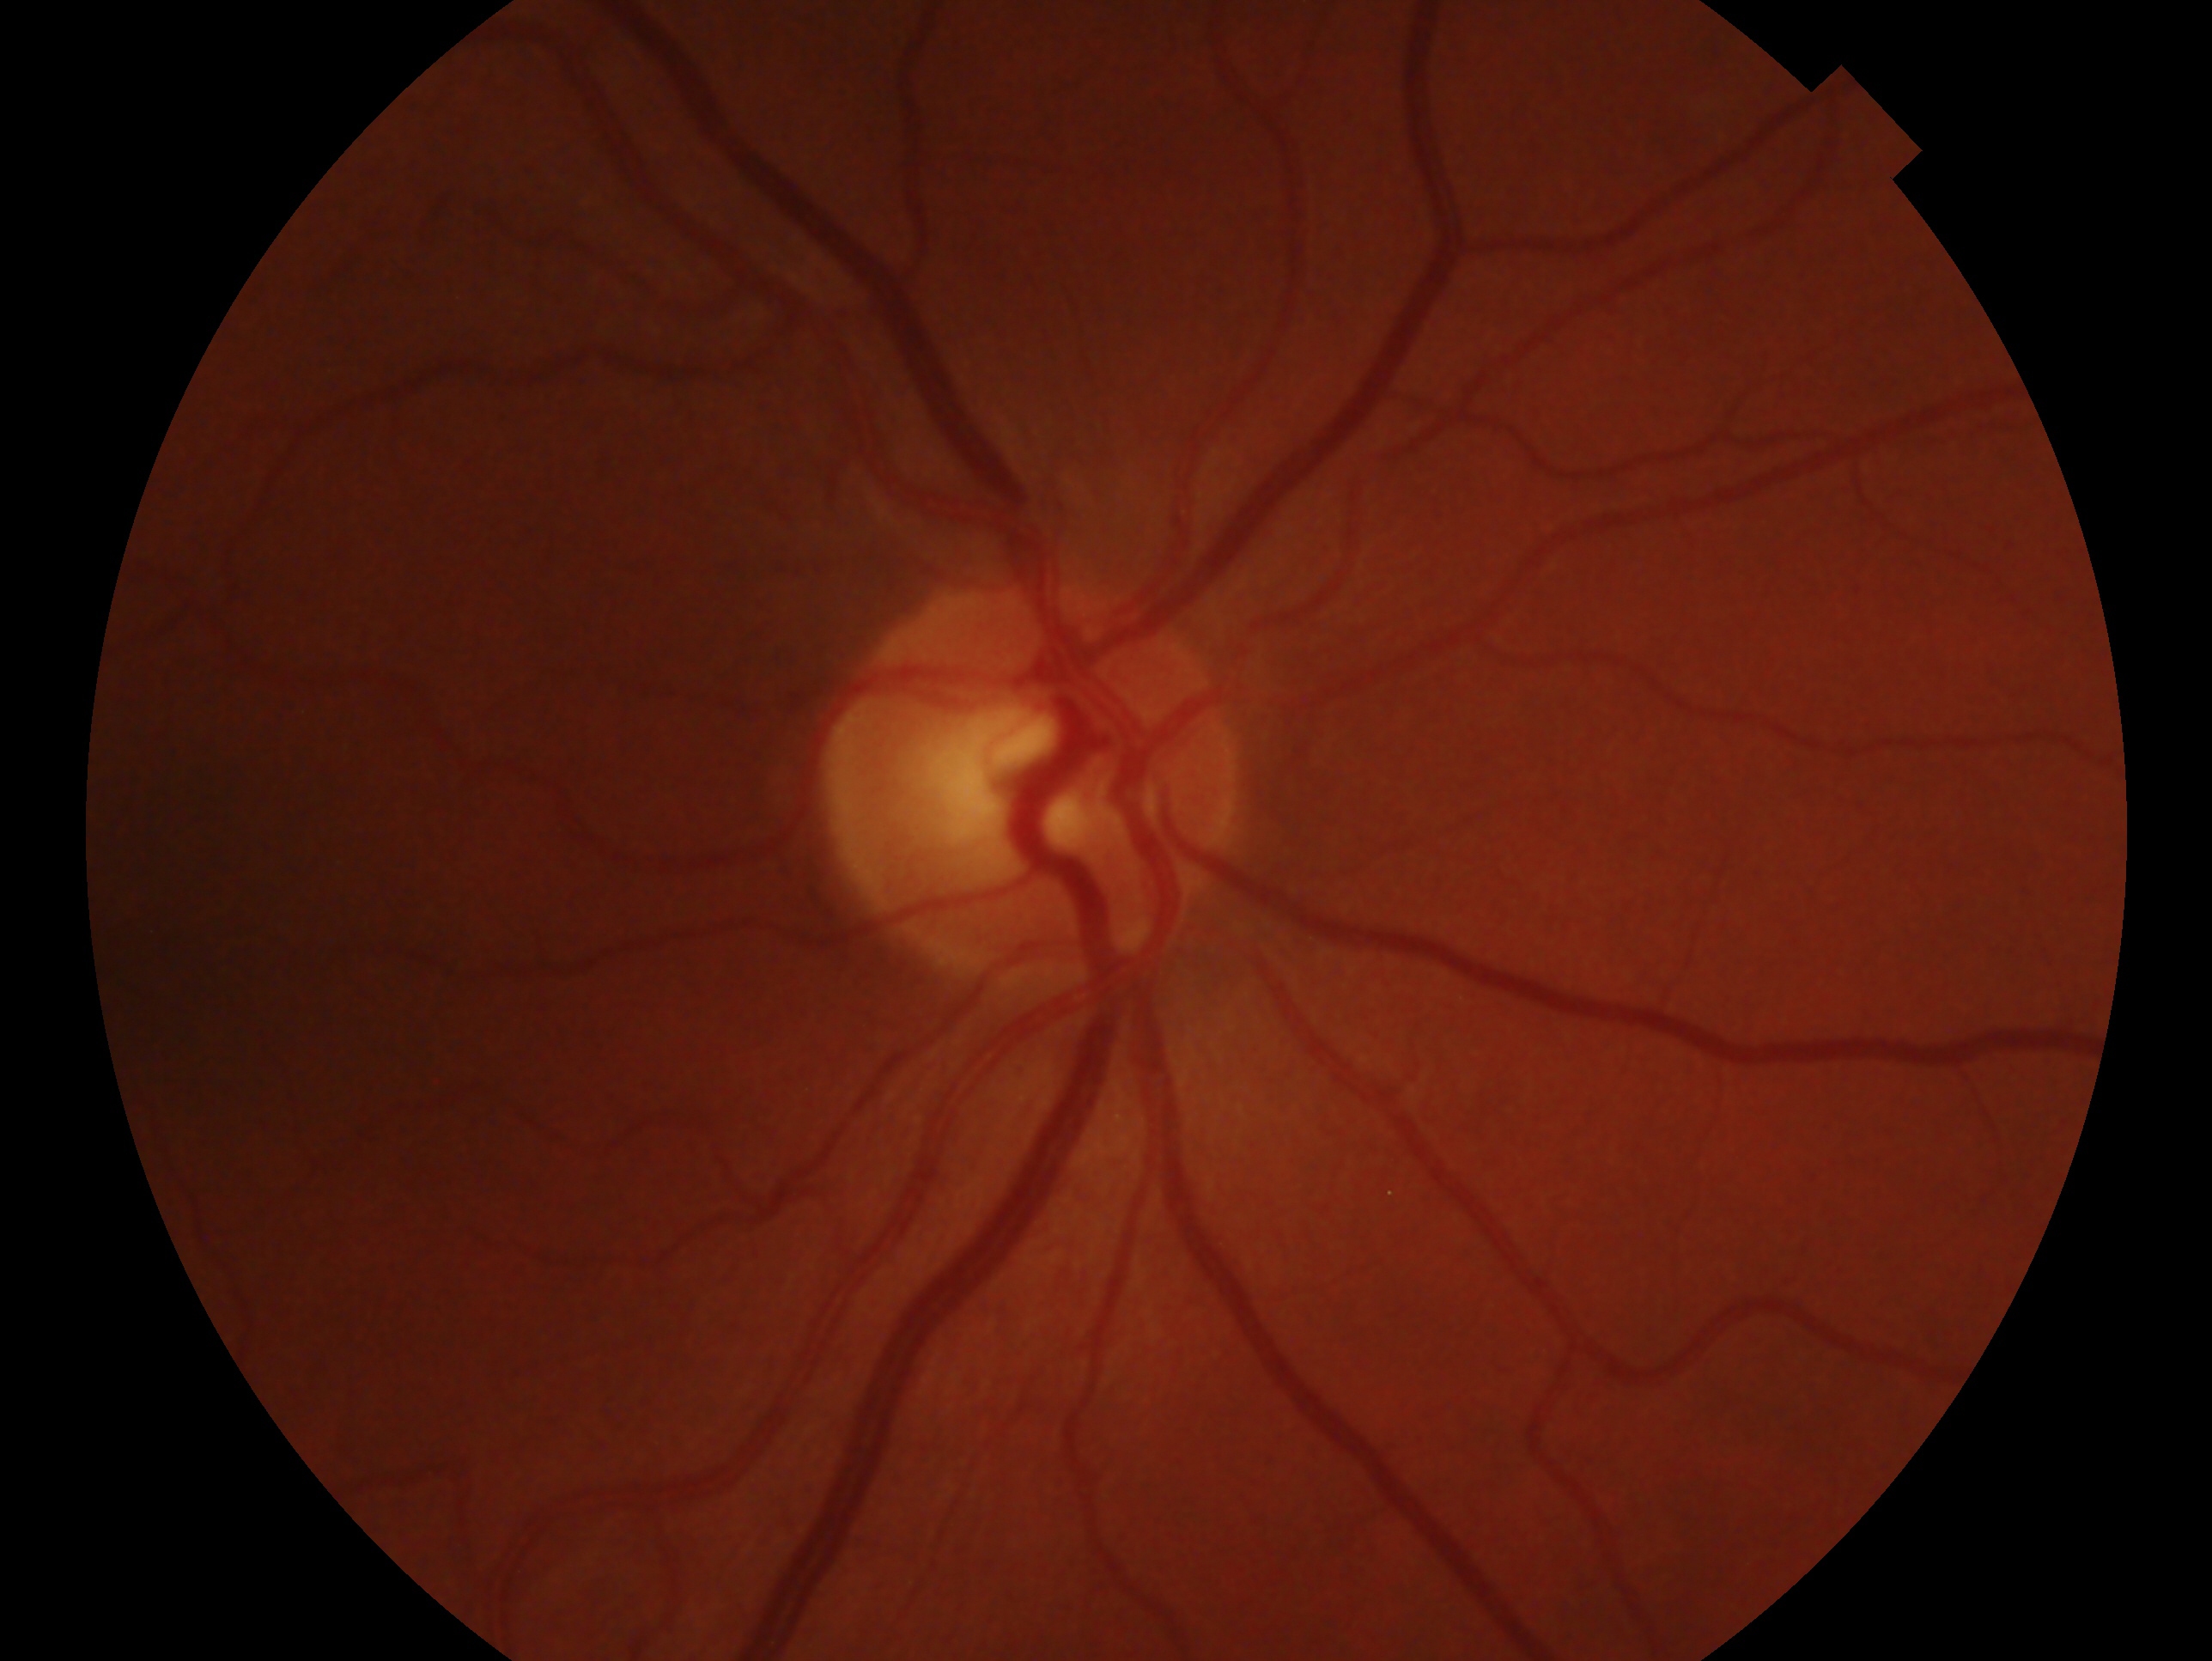
laterality = right
diagnosis = glaucoma suspect